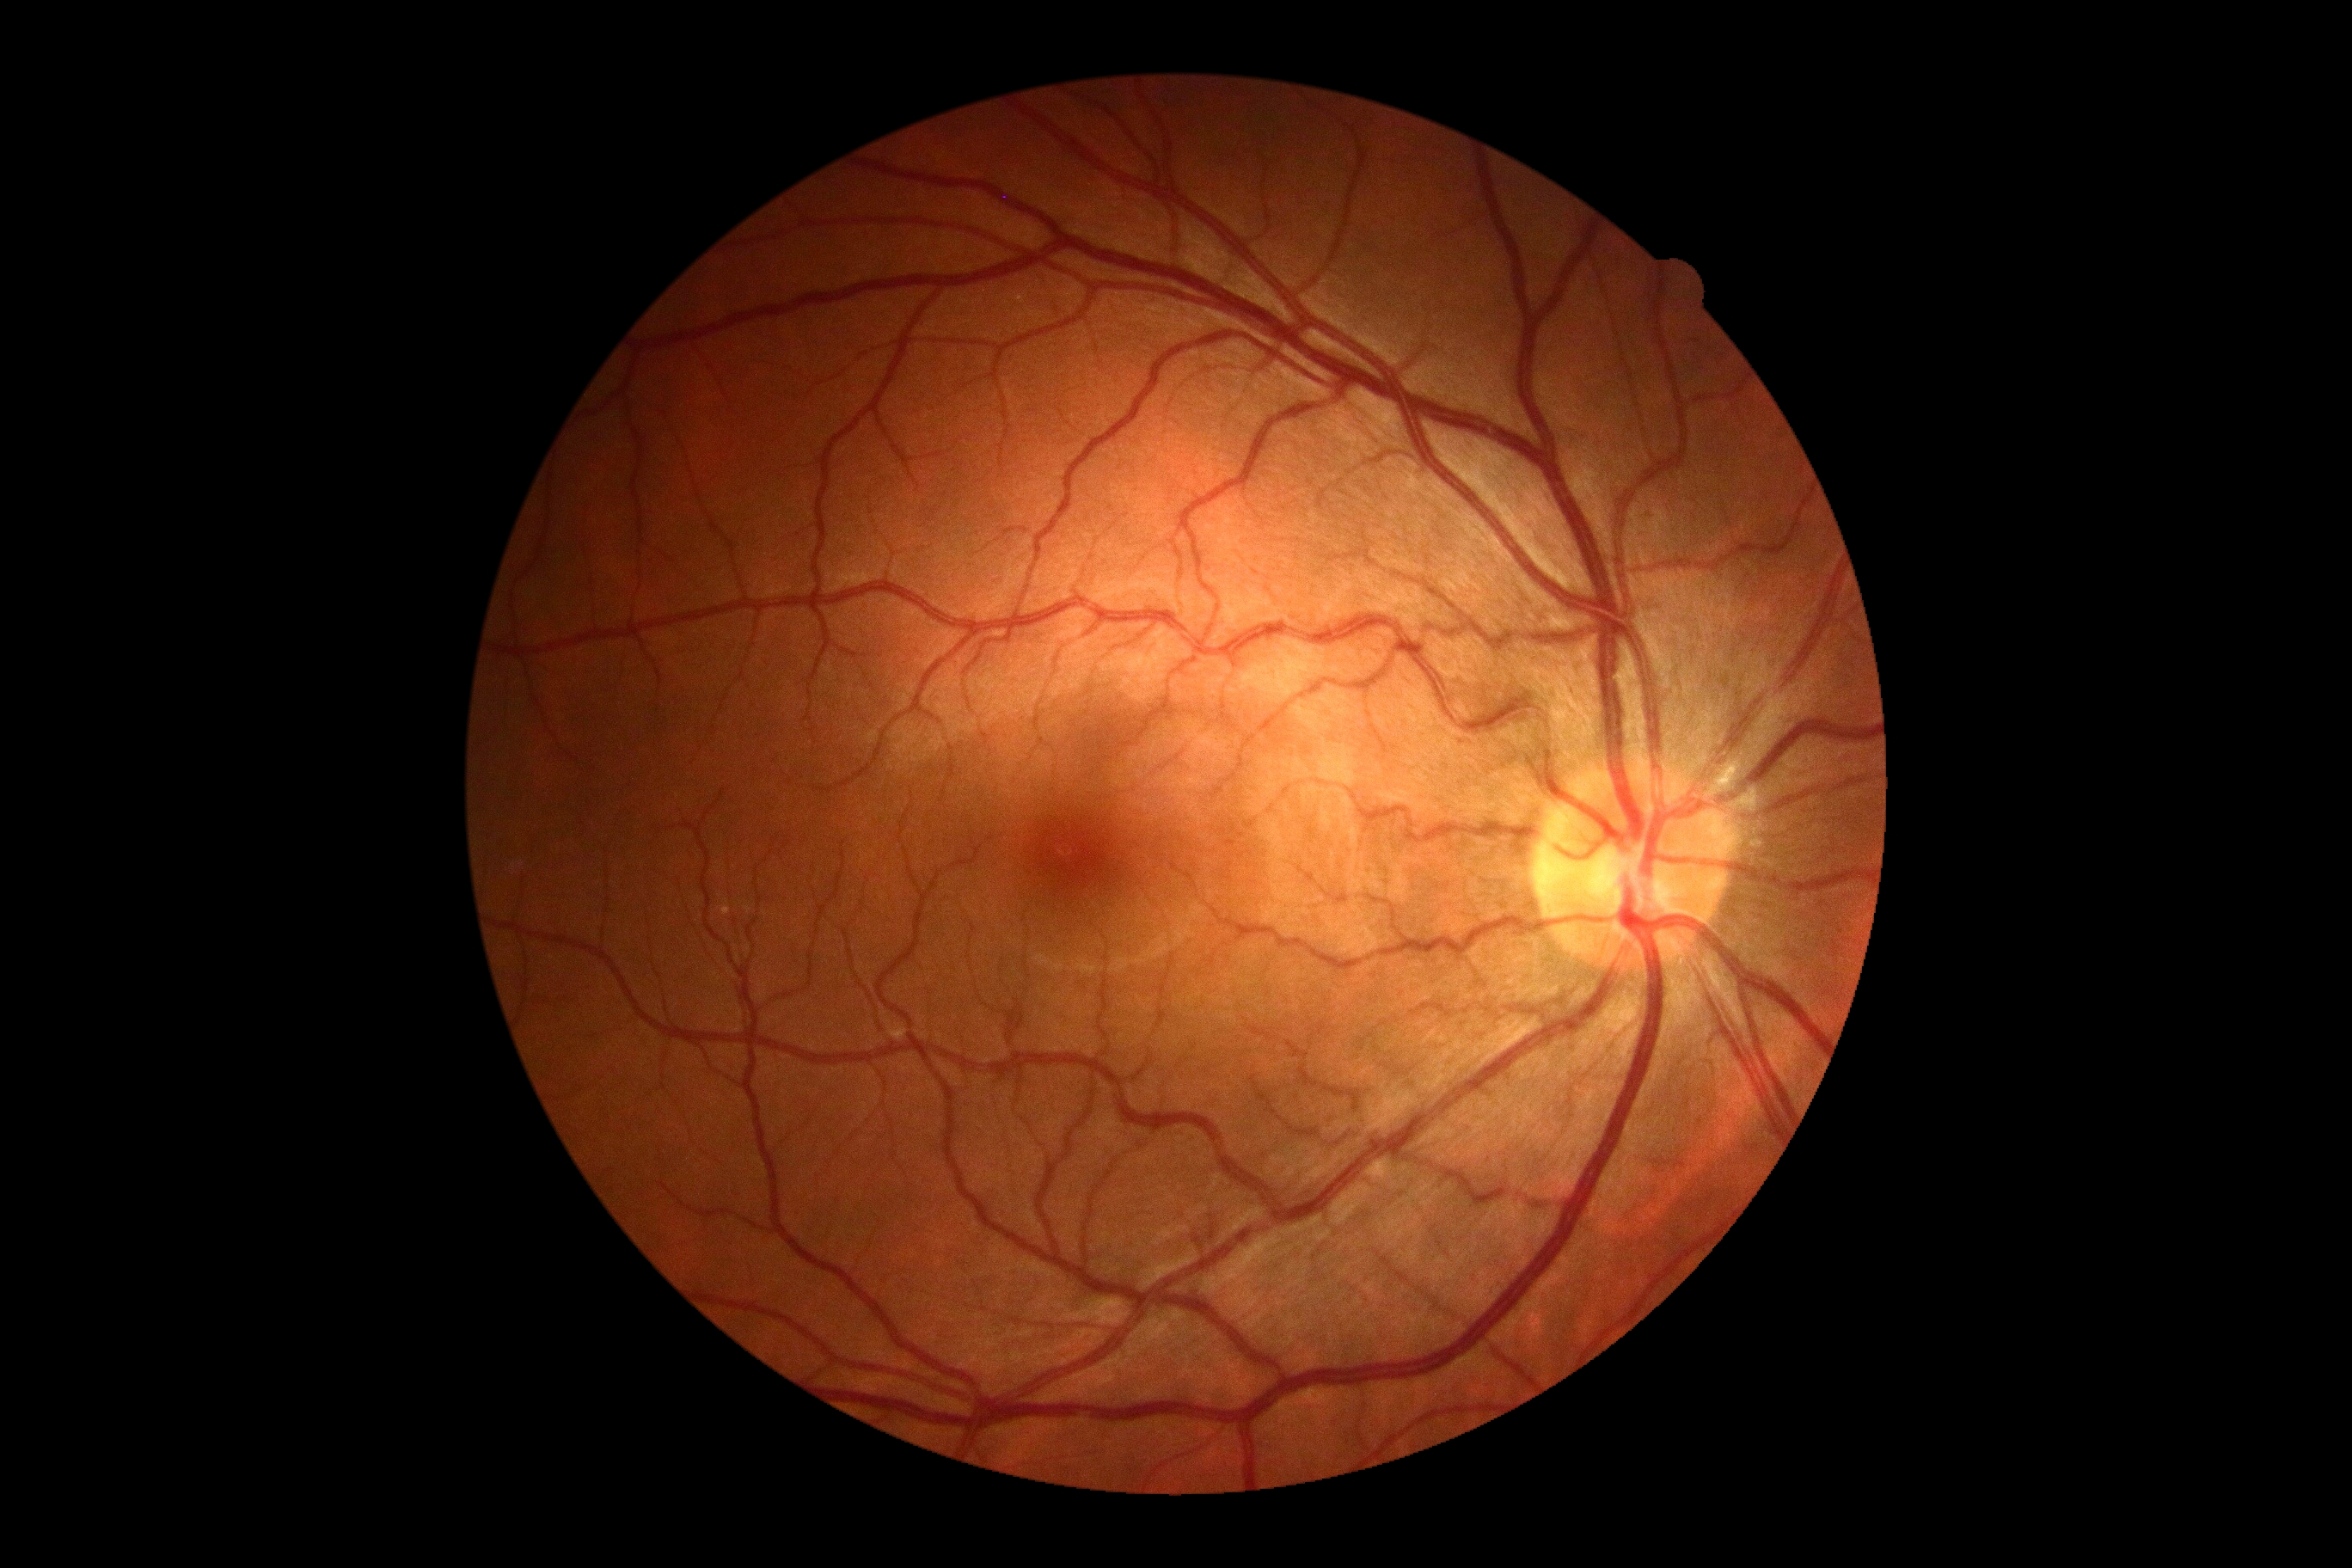

{
  "dr_grade": "no apparent retinopathy (grade 0)",
  "dr_impression": "no apparent DR"
}